Optic disc-centered crop. CFP.
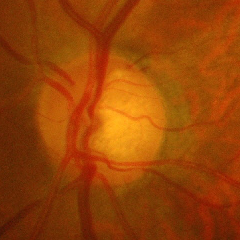

Glaucoma is present. Demonstrates advanced-stage glaucoma.